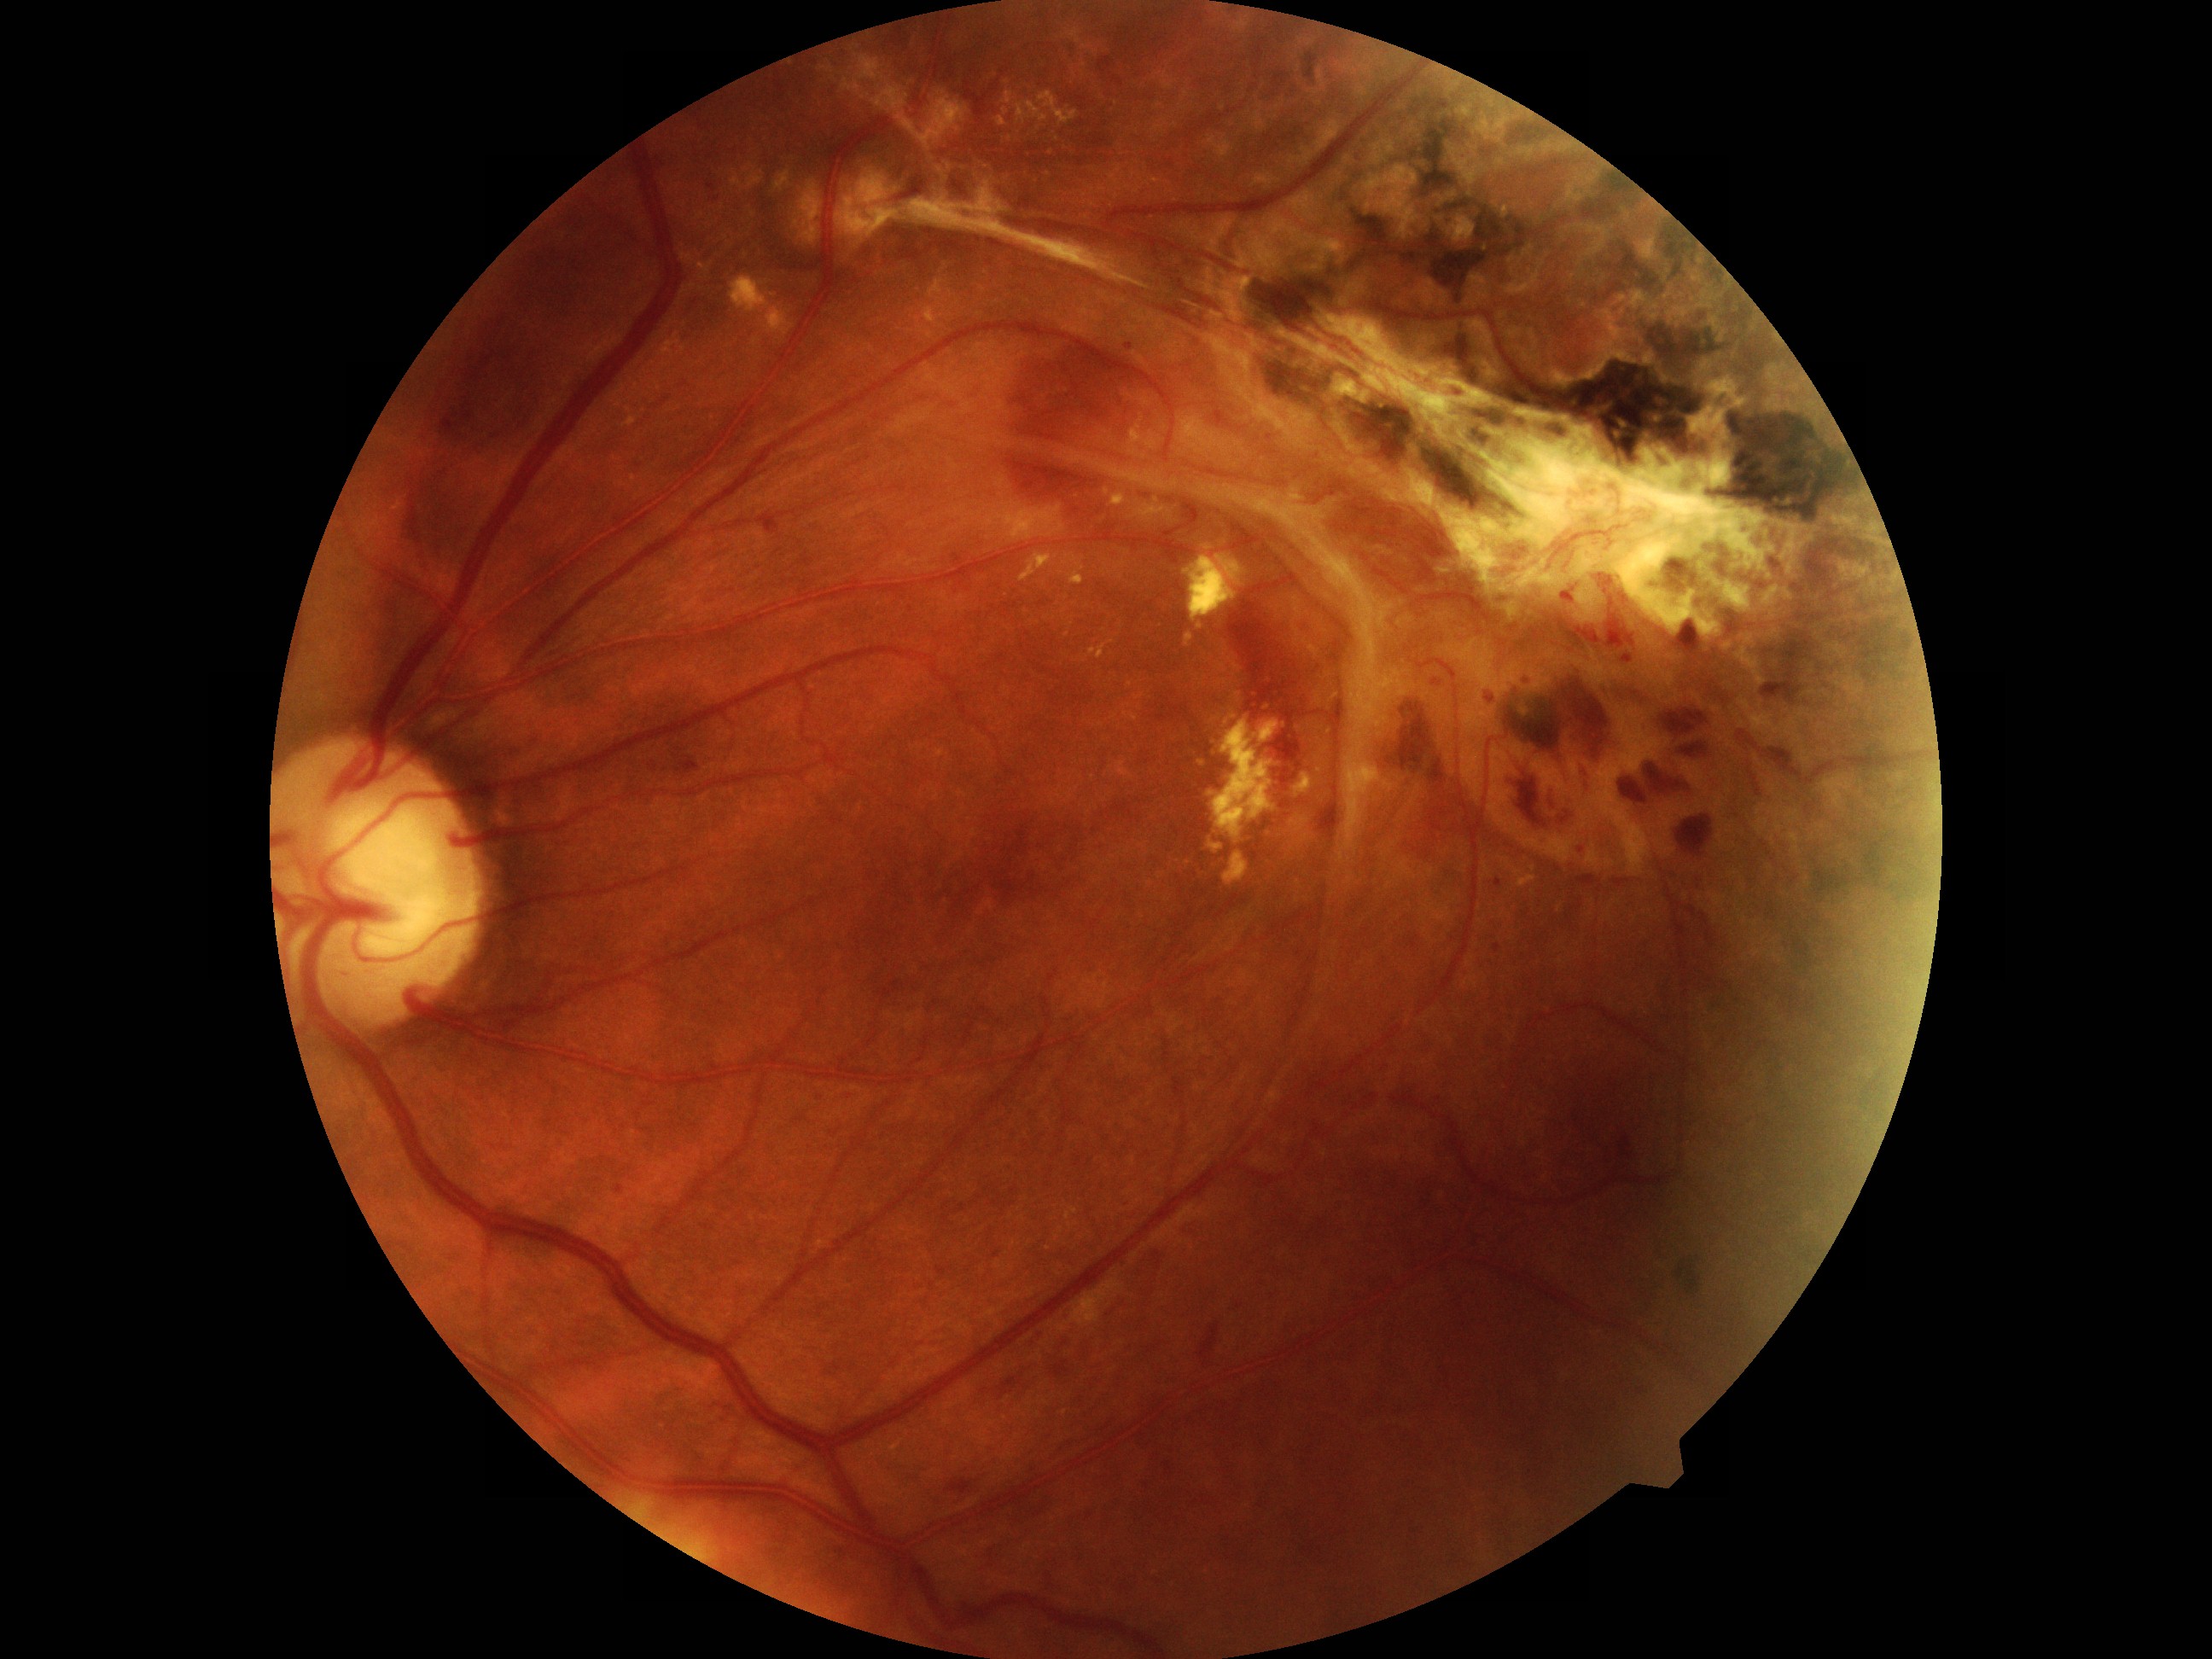 Diabetic retinopathy grade is 4/4 — neovascularization and/or vitreous/pre-retinal hemorrhage.